Color fundus photograph · 2352x1568px:
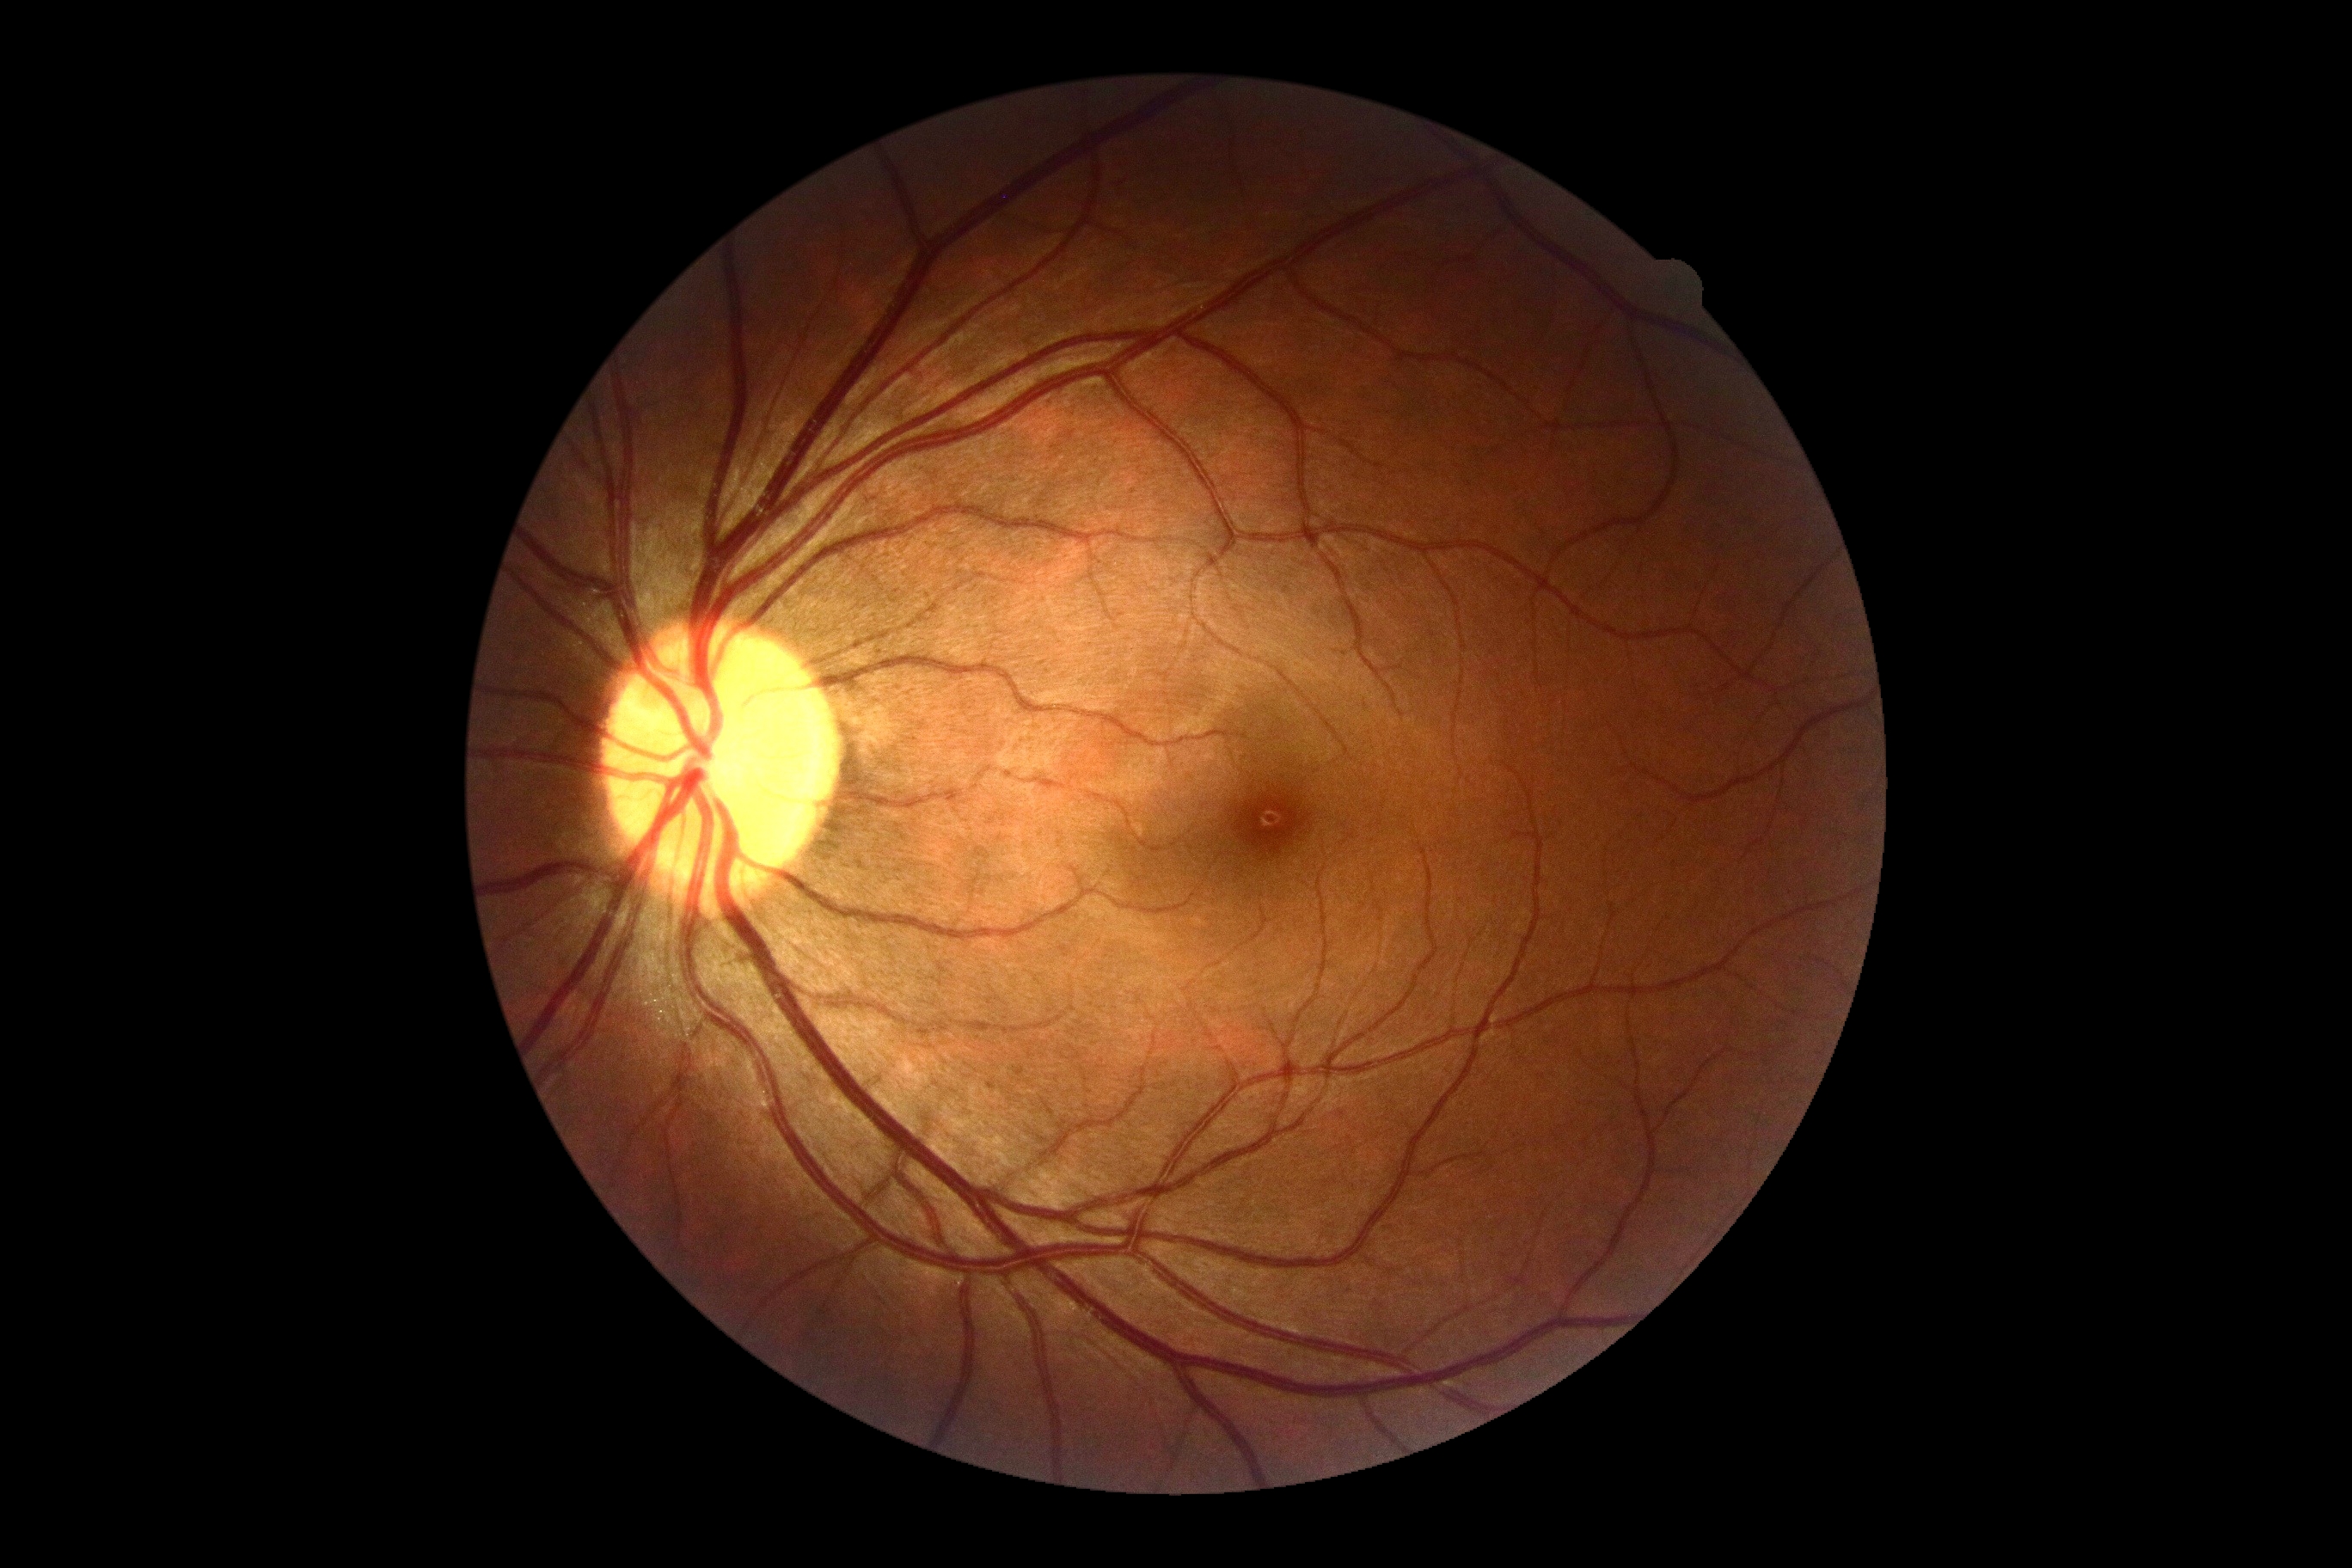
DR impression = no apparent DR; DR grade = 0 (no apparent retinopathy).